Color fundus photograph: 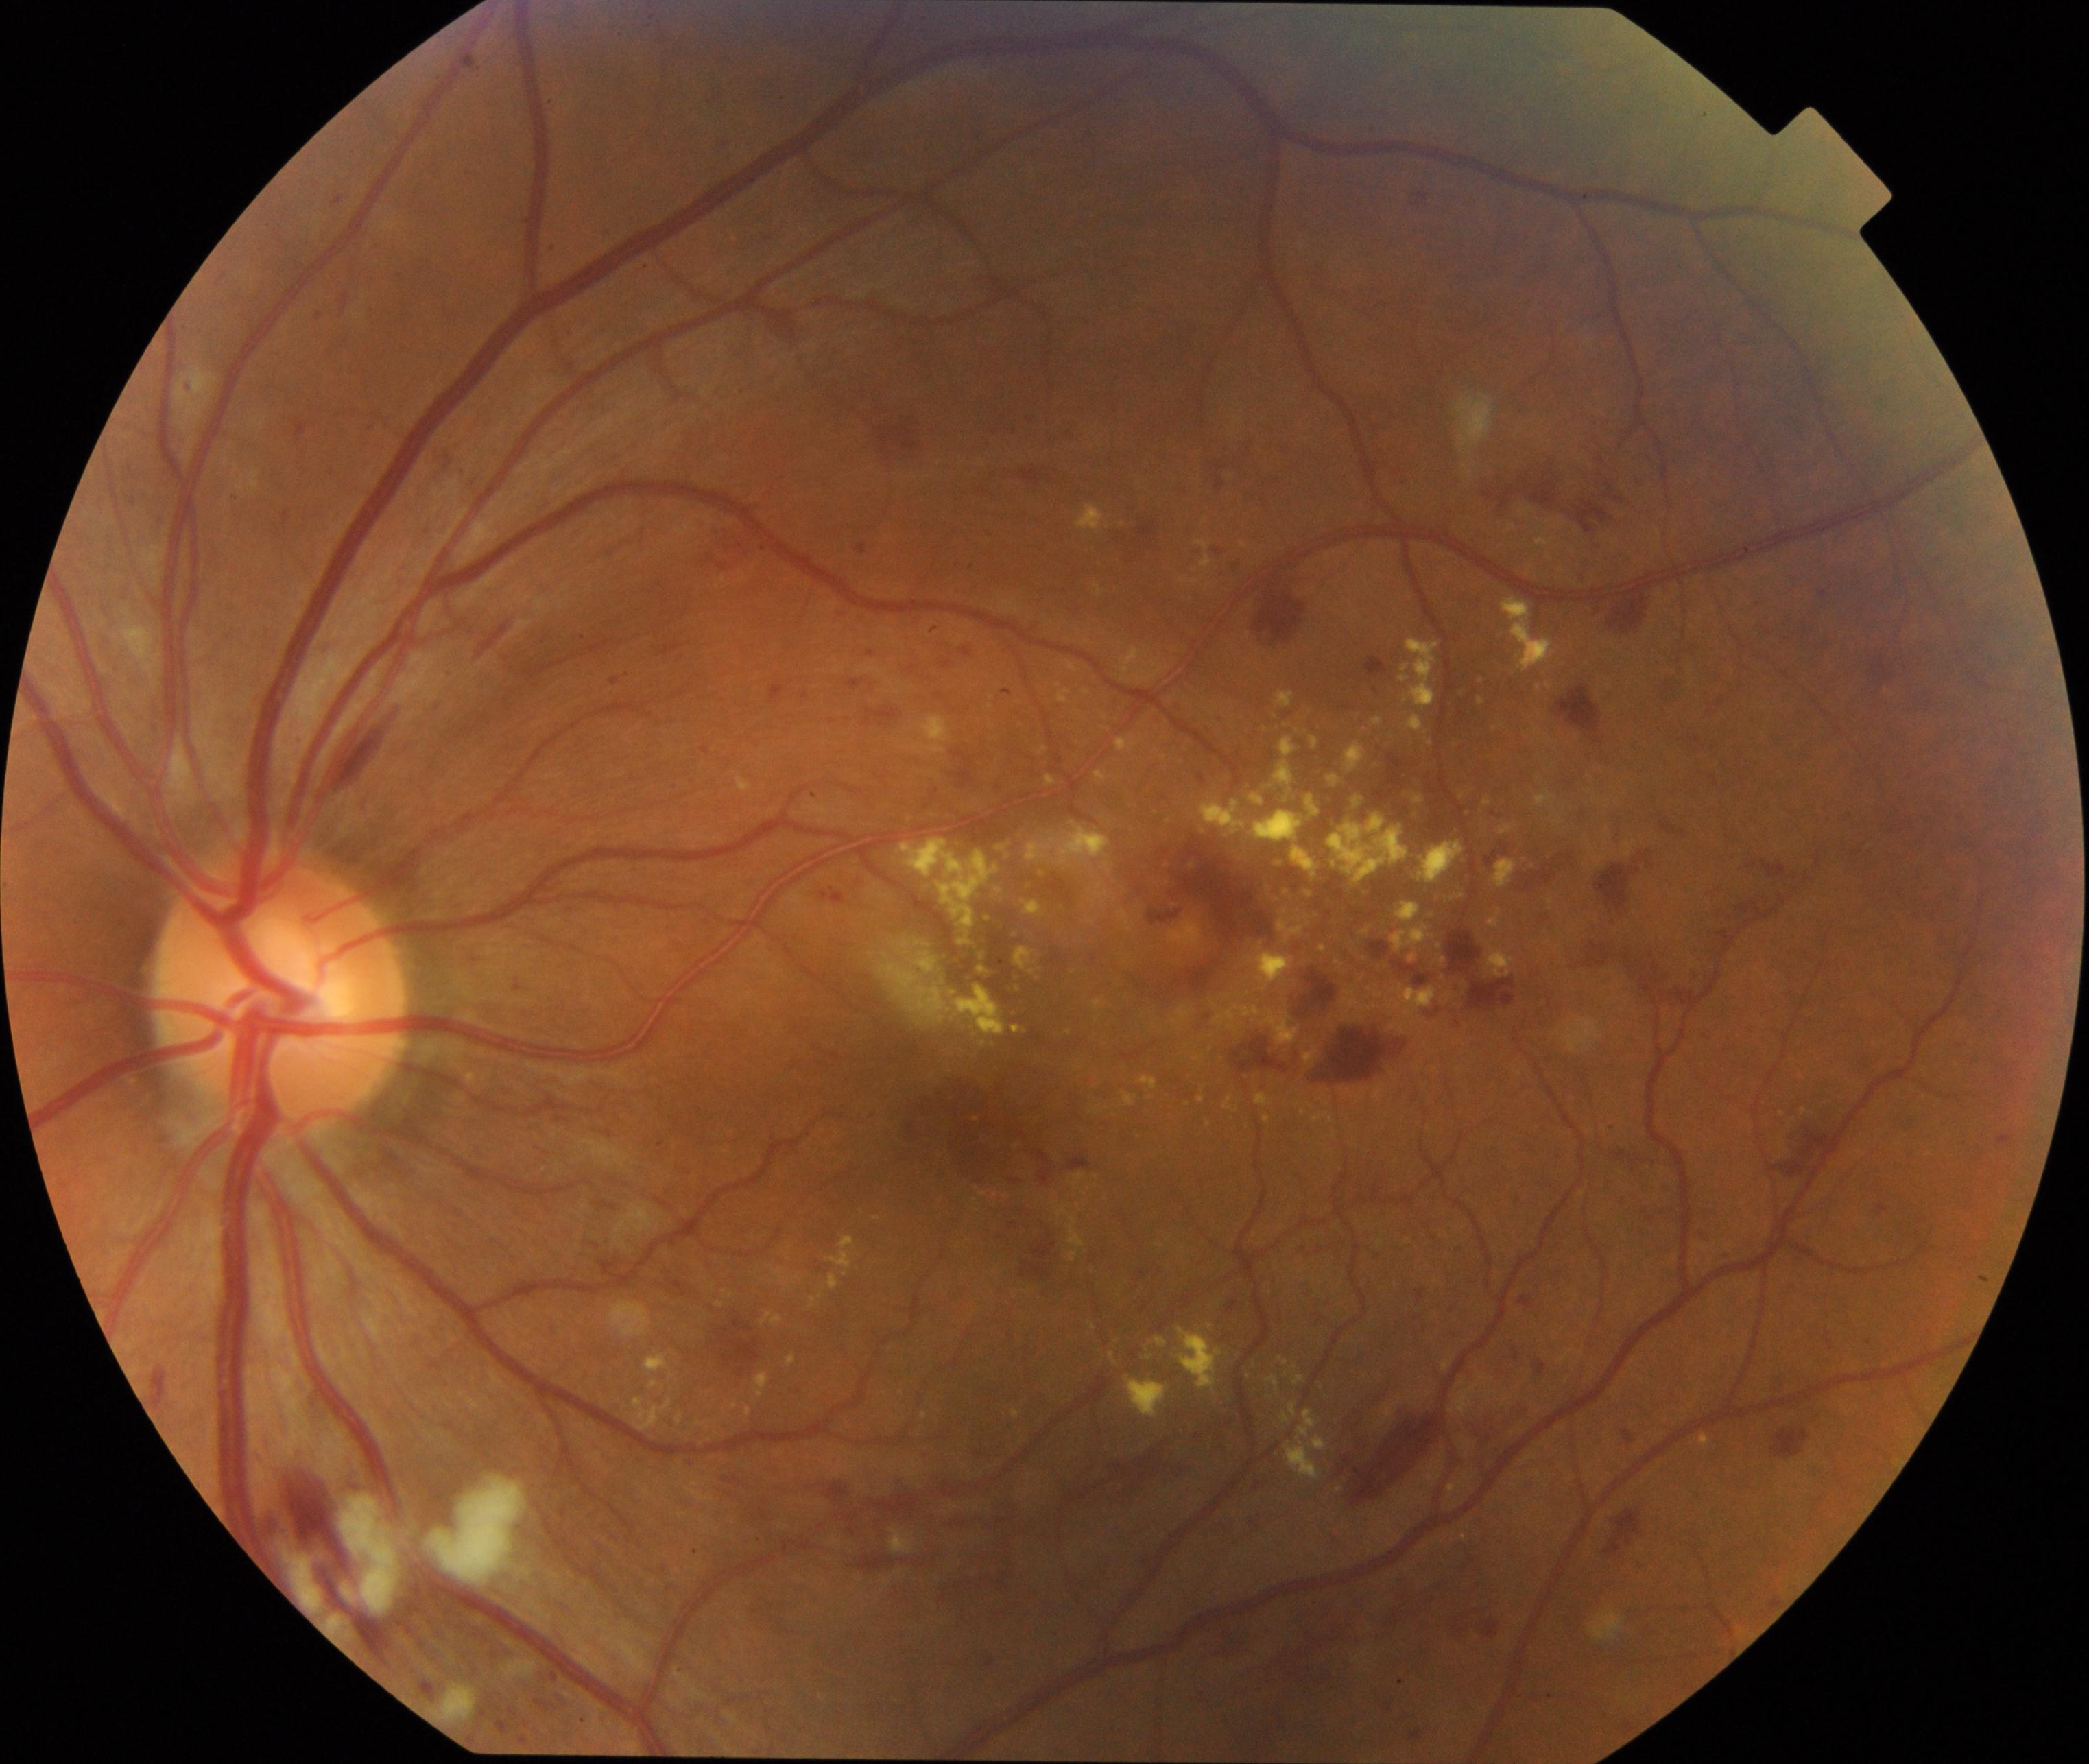

Demonstrates moderate non-proliferative diabetic retinopathy. Characterized by microaneurysms with dot and blot hemorrhages or hard exudates, less than severe non-proliferative diabetic retinopathy, and/or with diabetic macular edema.